Non-mydriatic acquisition. Fundus photo
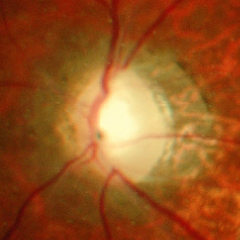 Glaucomatous changes are present. Assessment = severe glaucomatous damage.